Wide-field contact fundus photograph of an infant
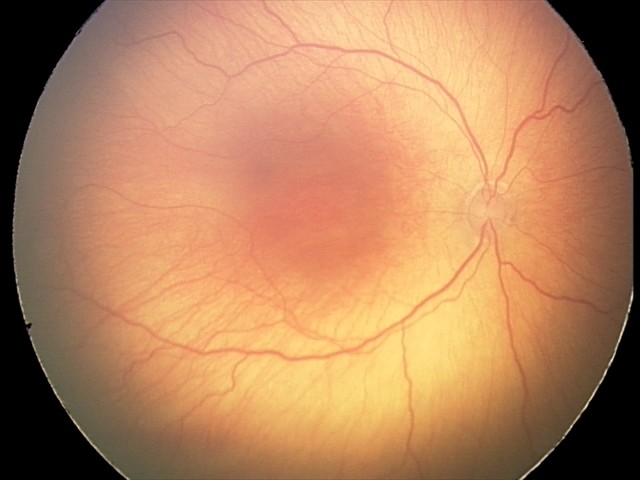

Without plus disease. From an examination with diagnosis of retinopathy of prematurity (ROP) stage 2.